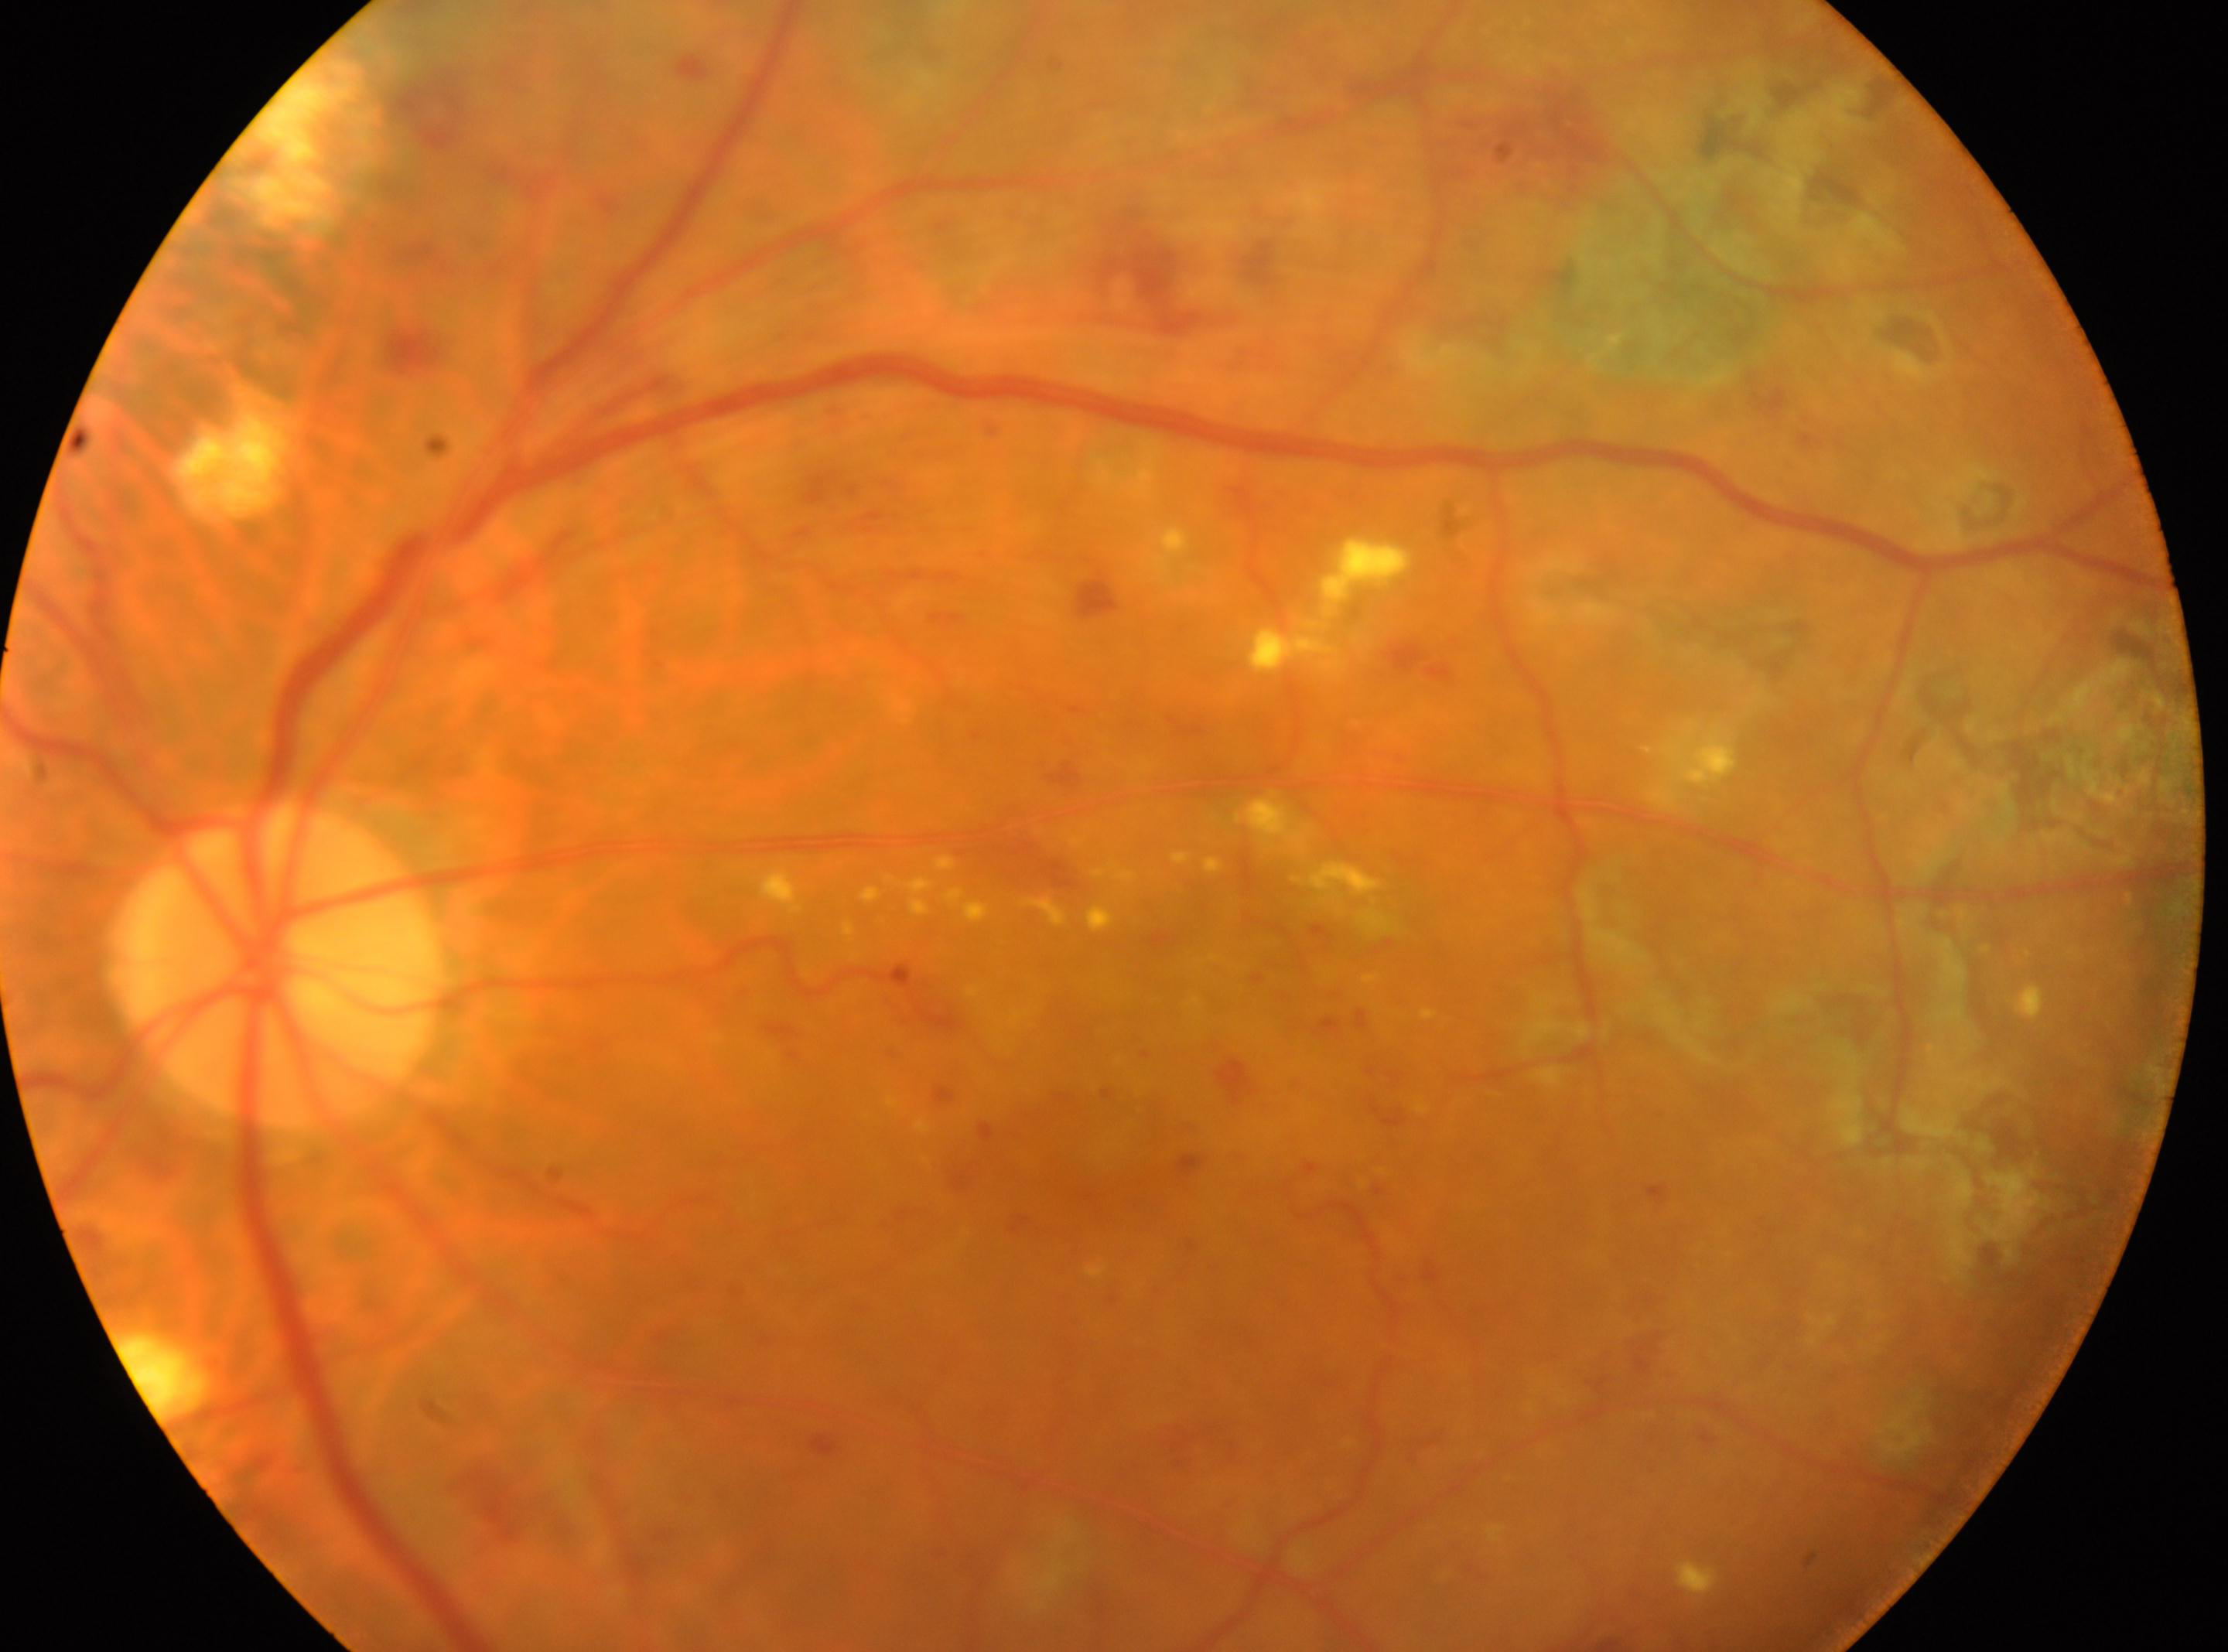 Q: Which eye is imaged?
A: left
Q: Diabetic retinopathy severity?
A: post-photocoagulation DR, underlying severity grade 3 (severe NPDR)
Q: Locate the optic disc.
A: (274,966)
Q: Locate the fovea.
A: (1046,1168)